Image size 2352x1568: 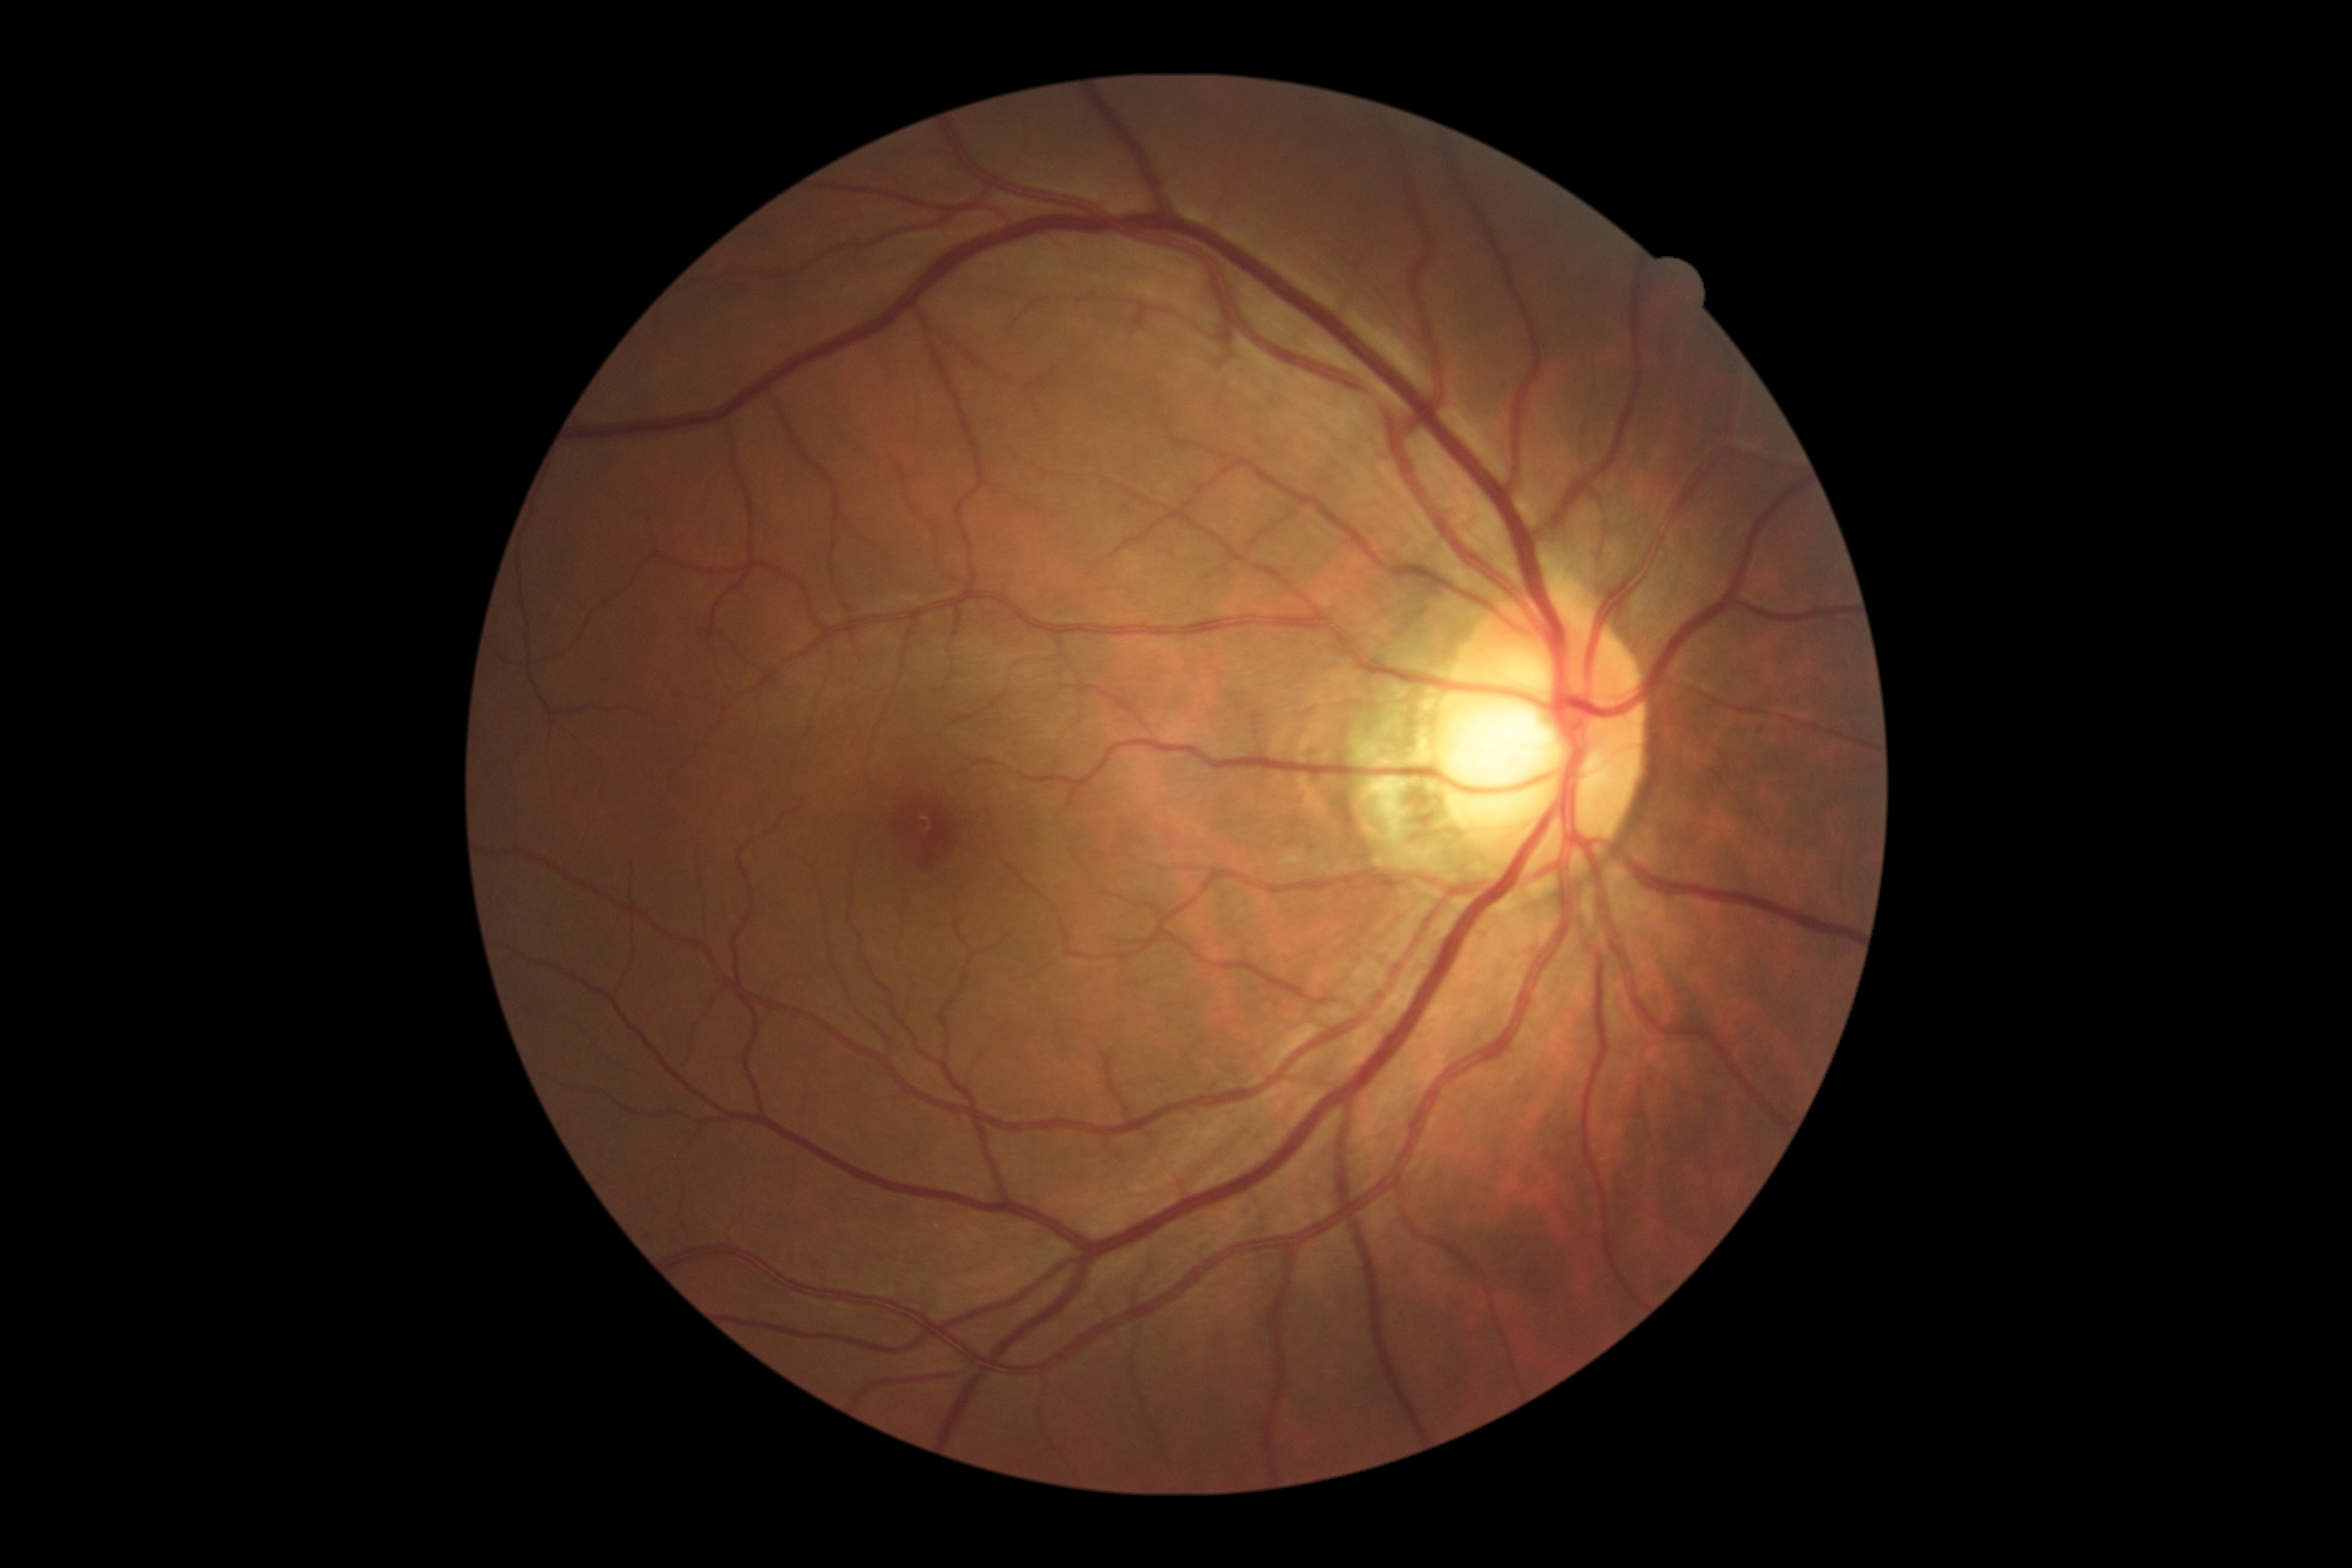
dr_grade: 0